Pediatric wide-field fundus photograph
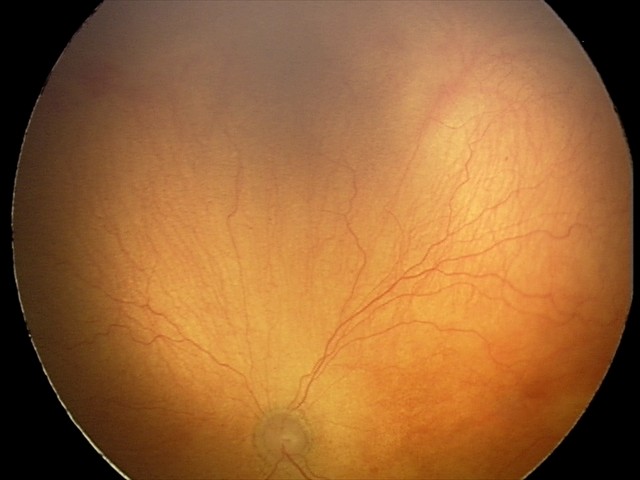

Screening: plus disease — abnormal dilation and tortuosity of the posterior pole retinal vessels | aggressive retinopathy of prematurity (A-ROP).